45-degree field of view
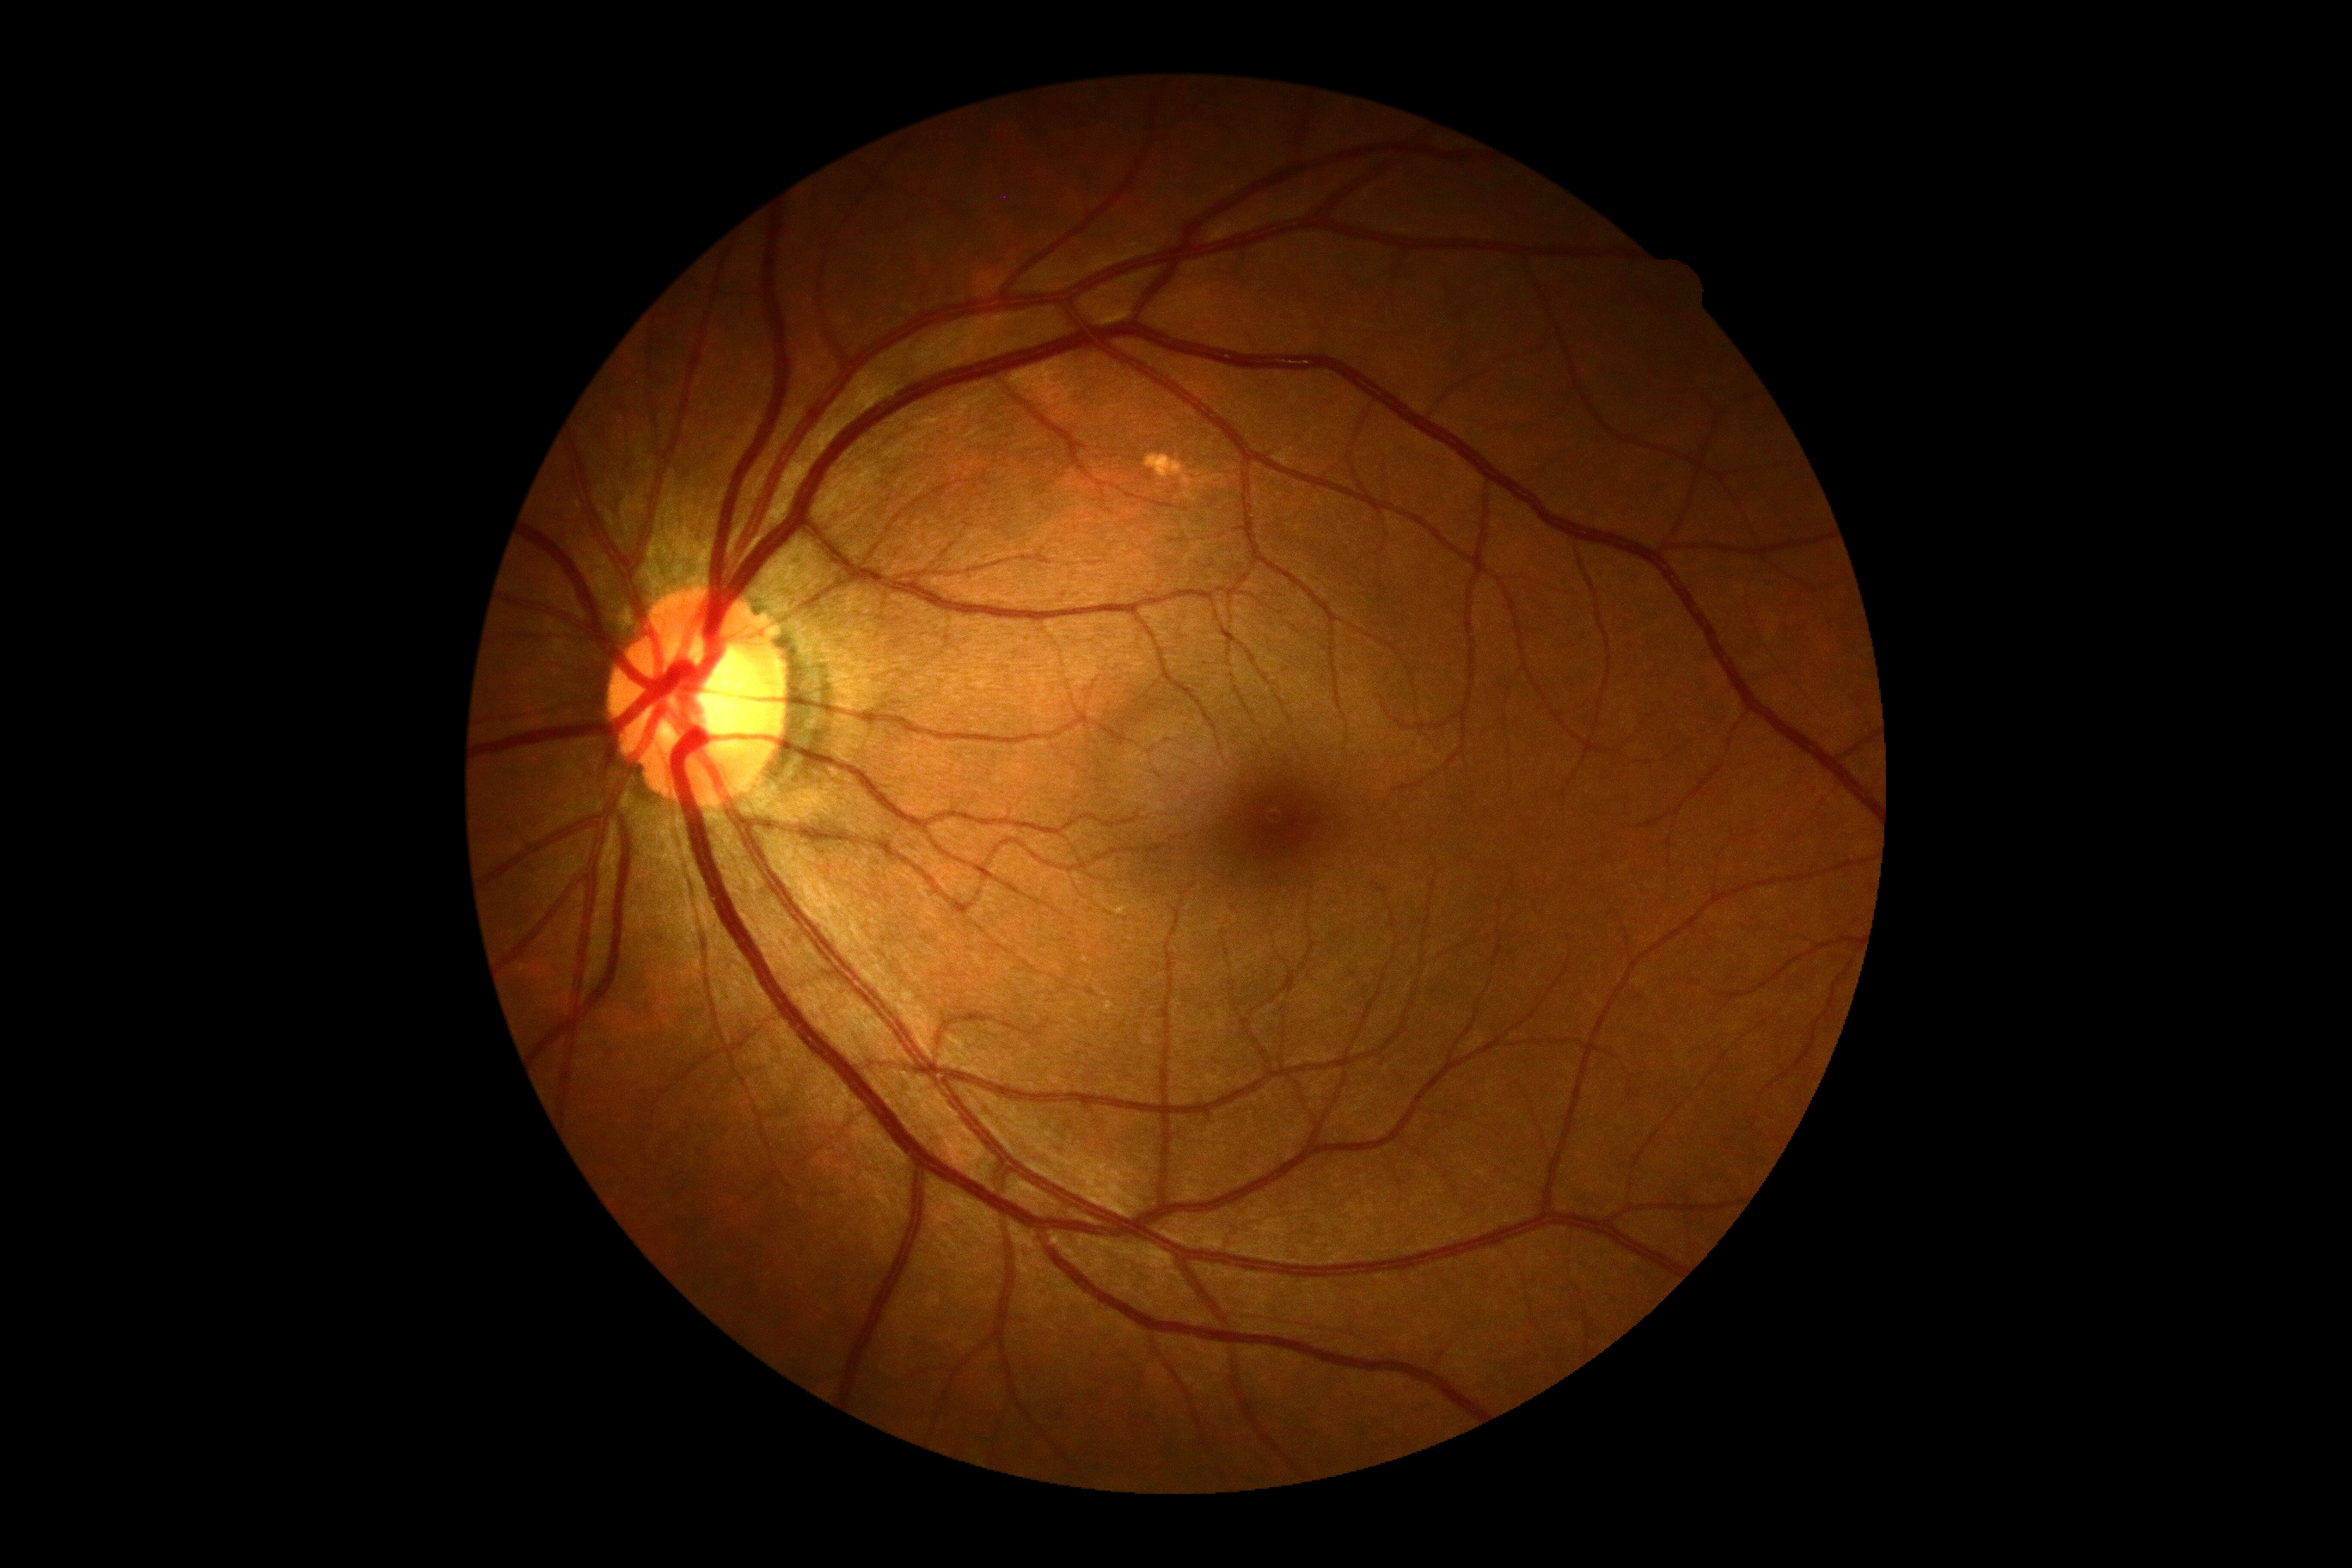
DR grade is 0.
No DR findings.